Diabetic retinopathy graded by the modified Davis classification
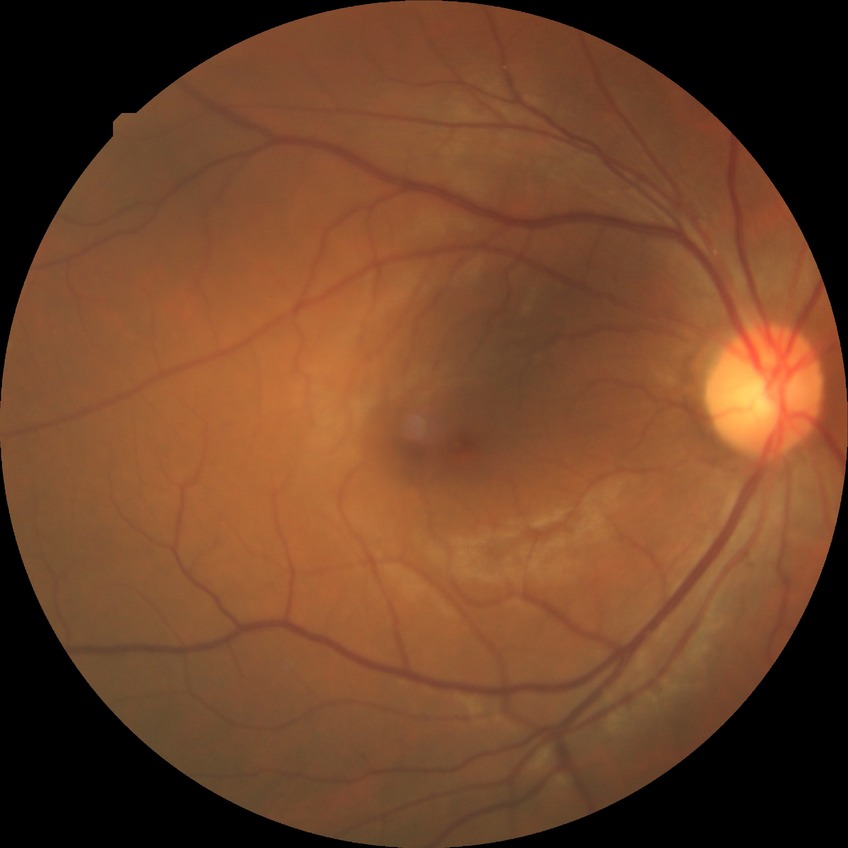

Diabetic retinopathy stage: no diabetic retinopathy.